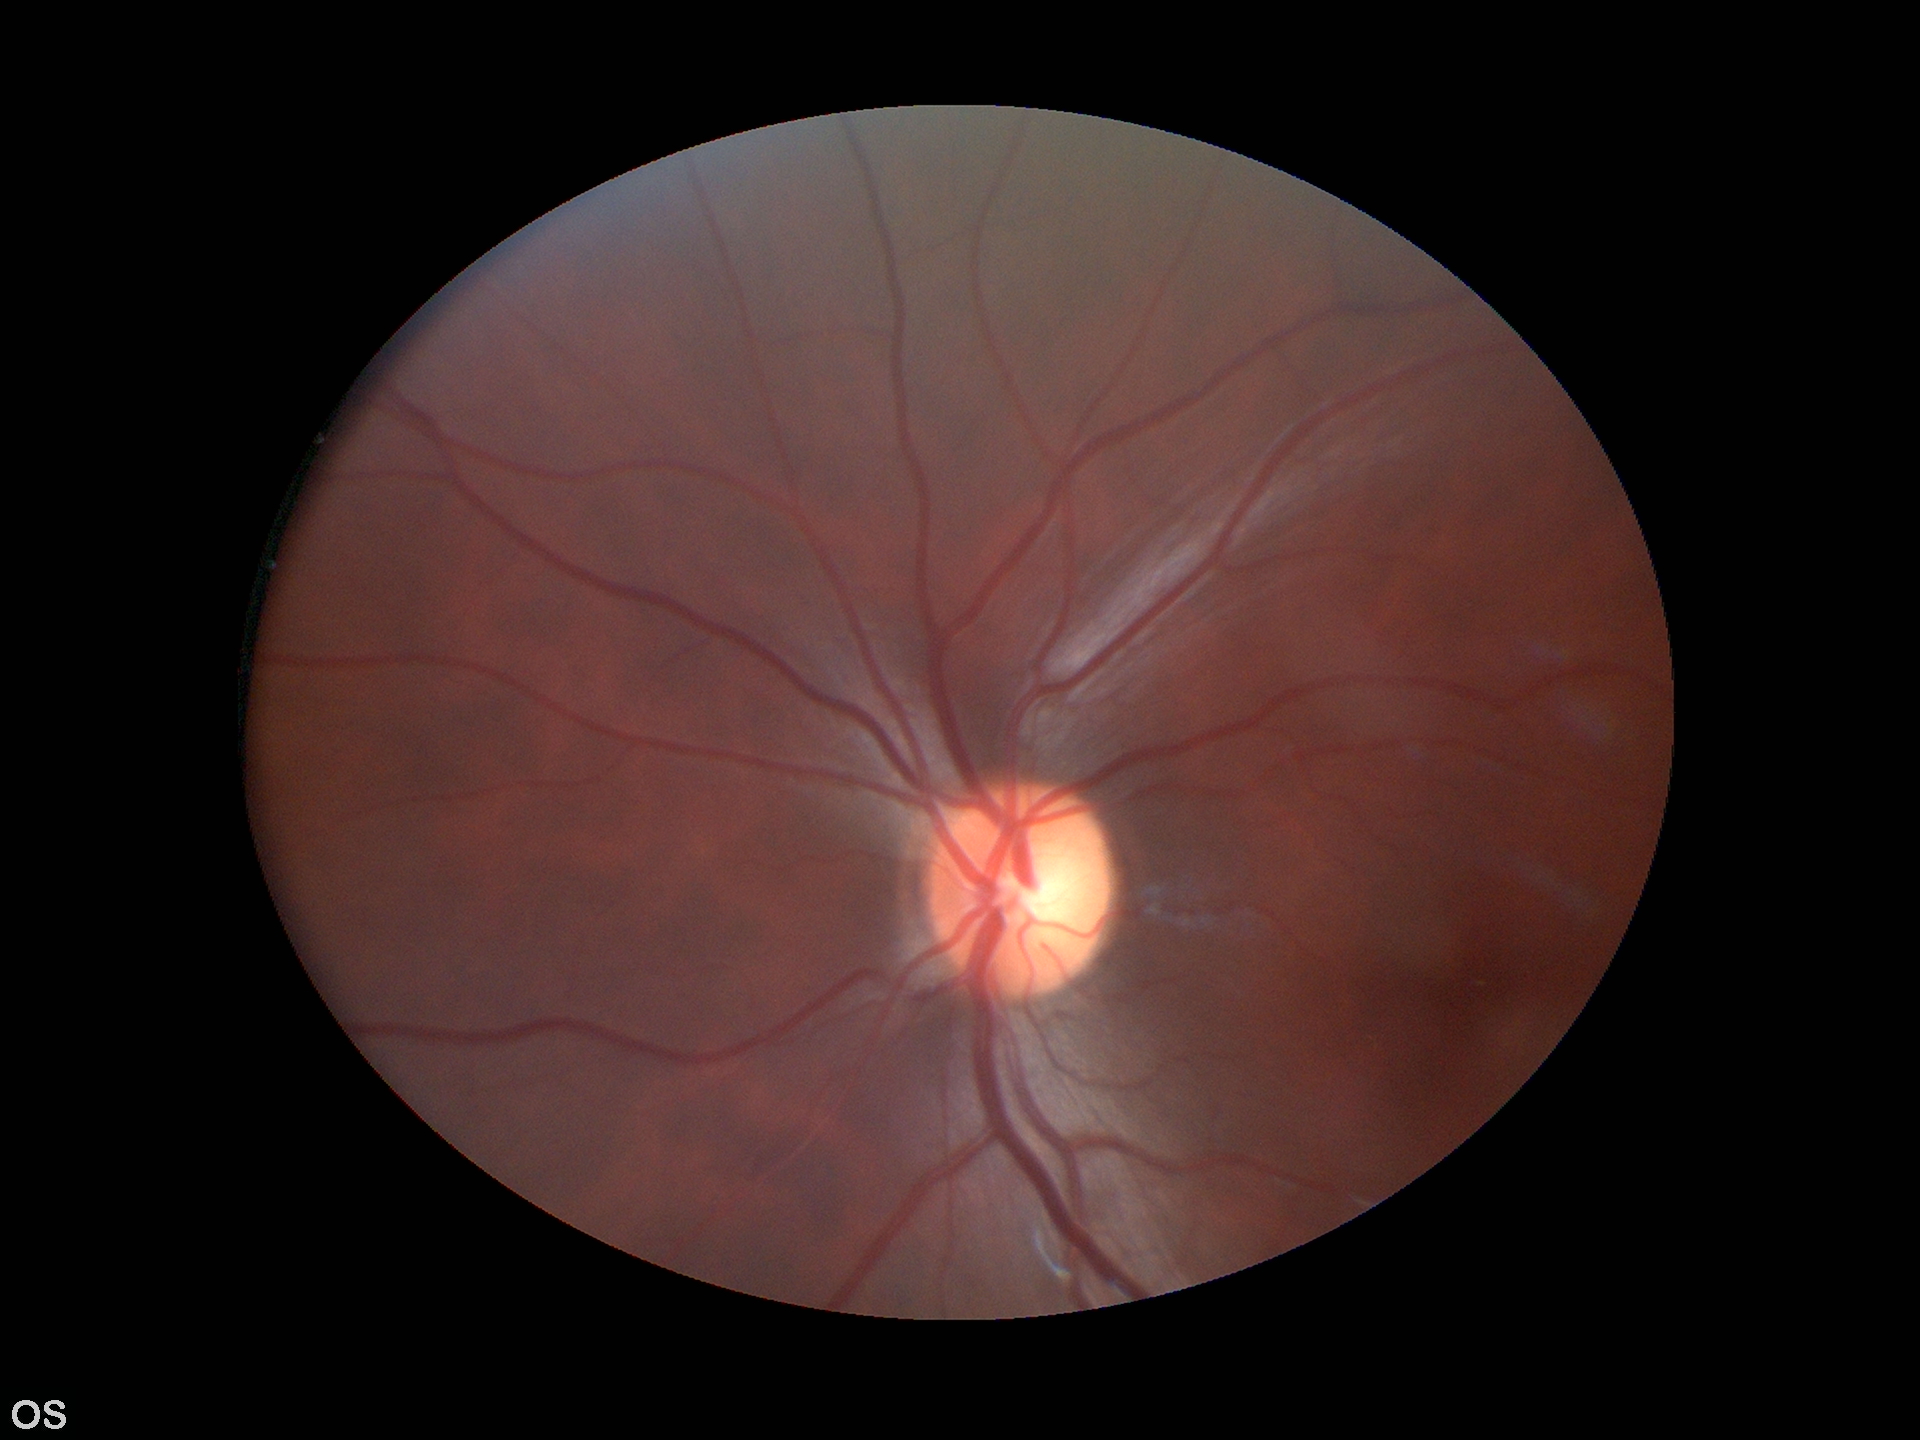 Optic disc analysis:
• Glaucoma screening: negative (all 5 graders called normal)
• vertical cup-to-disc ratio (VCDR): 0.48
• horizontal CDR (HCDR): 0.55